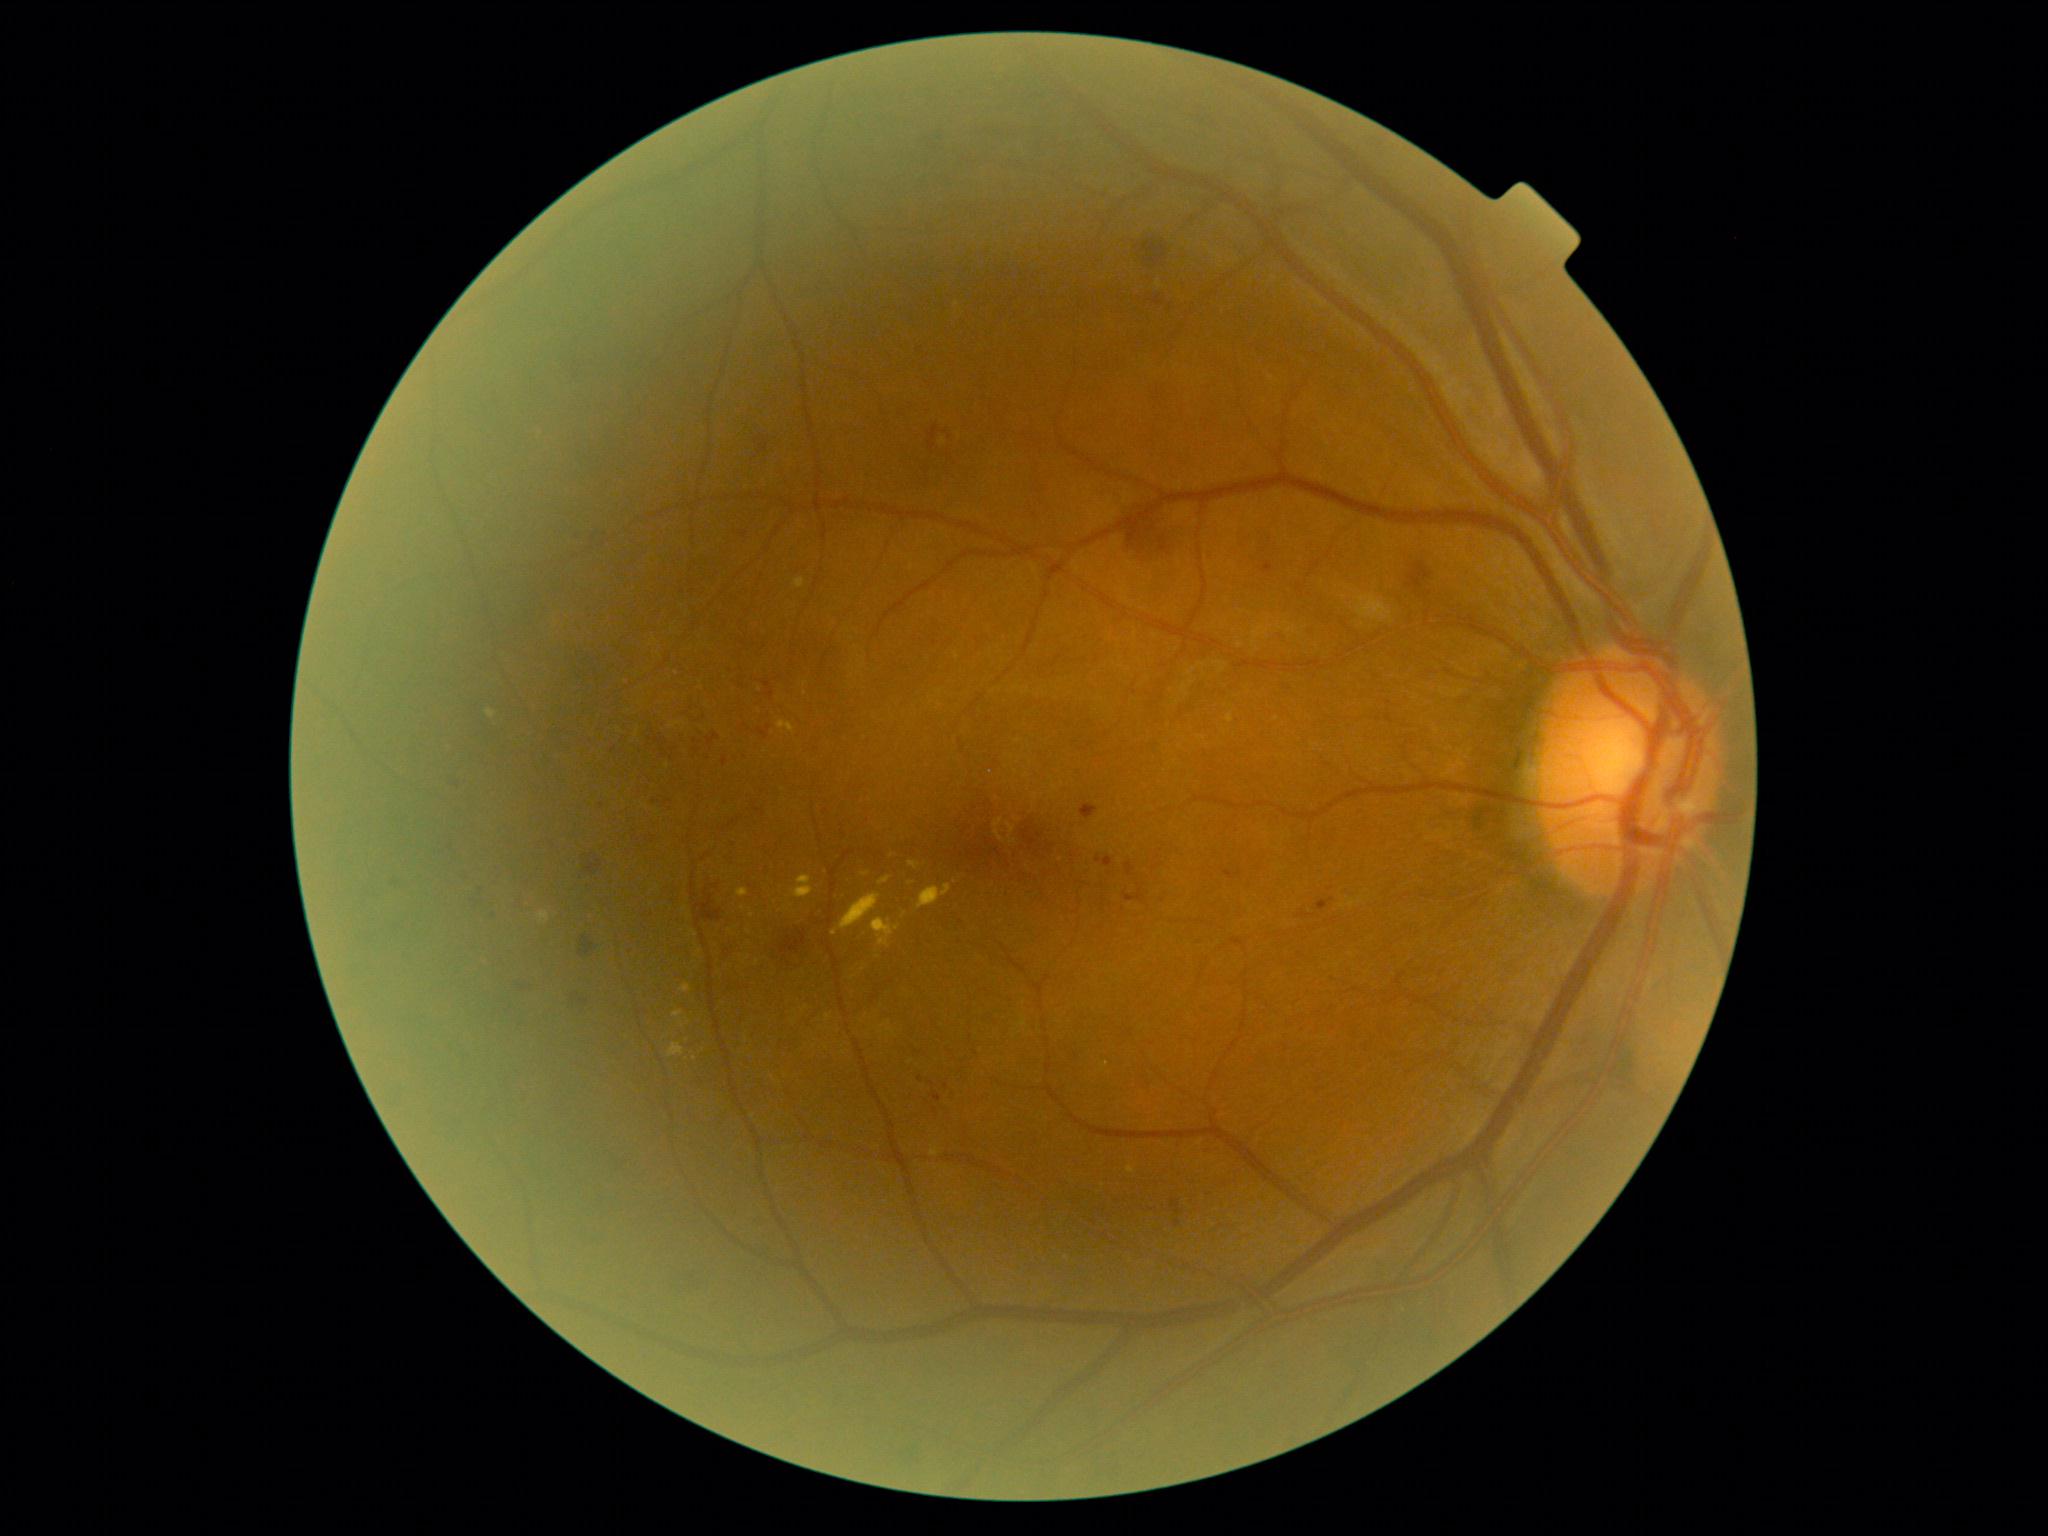
partial: true
dr_grade: 2
lesions:
  he:
    - [left=451, top=778, right=459, bottom=788]
    - [left=388, top=878, right=407, bottom=891]
    - [left=579, top=935, right=596, bottom=957]
    - [left=693, top=733, right=720, bottom=759]
    - [left=734, top=678, right=743, bottom=686]
    - [left=721, top=933, right=740, bottom=963]
    - [left=510, top=979, right=532, bottom=987]
    - [left=1407, top=562, right=1432, bottom=595]
    - [left=645, top=732, right=681, bottom=762]
    - [left=645, top=835, right=657, bottom=844]
    - [left=759, top=726, right=772, bottom=740]
    - [left=571, top=997, right=588, bottom=1009]
    - [left=754, top=434, right=769, bottom=455]
  he_small:
    - (x=1177, y=1223)
  ex:
    - [left=910, top=861, right=920, bottom=868]
    - [left=777, top=720, right=795, bottom=733]
    - [left=918, top=884, right=953, bottom=910]
    - [left=792, top=875, right=813, bottom=898]
    - [left=879, top=877, right=891, bottom=885]
    - [left=486, top=709, right=496, bottom=719]
    - [left=737, top=888, right=749, bottom=898]
  ex_small:
    - (x=688, y=1040)
    - (x=835, y=933)
    - (x=904, y=915)